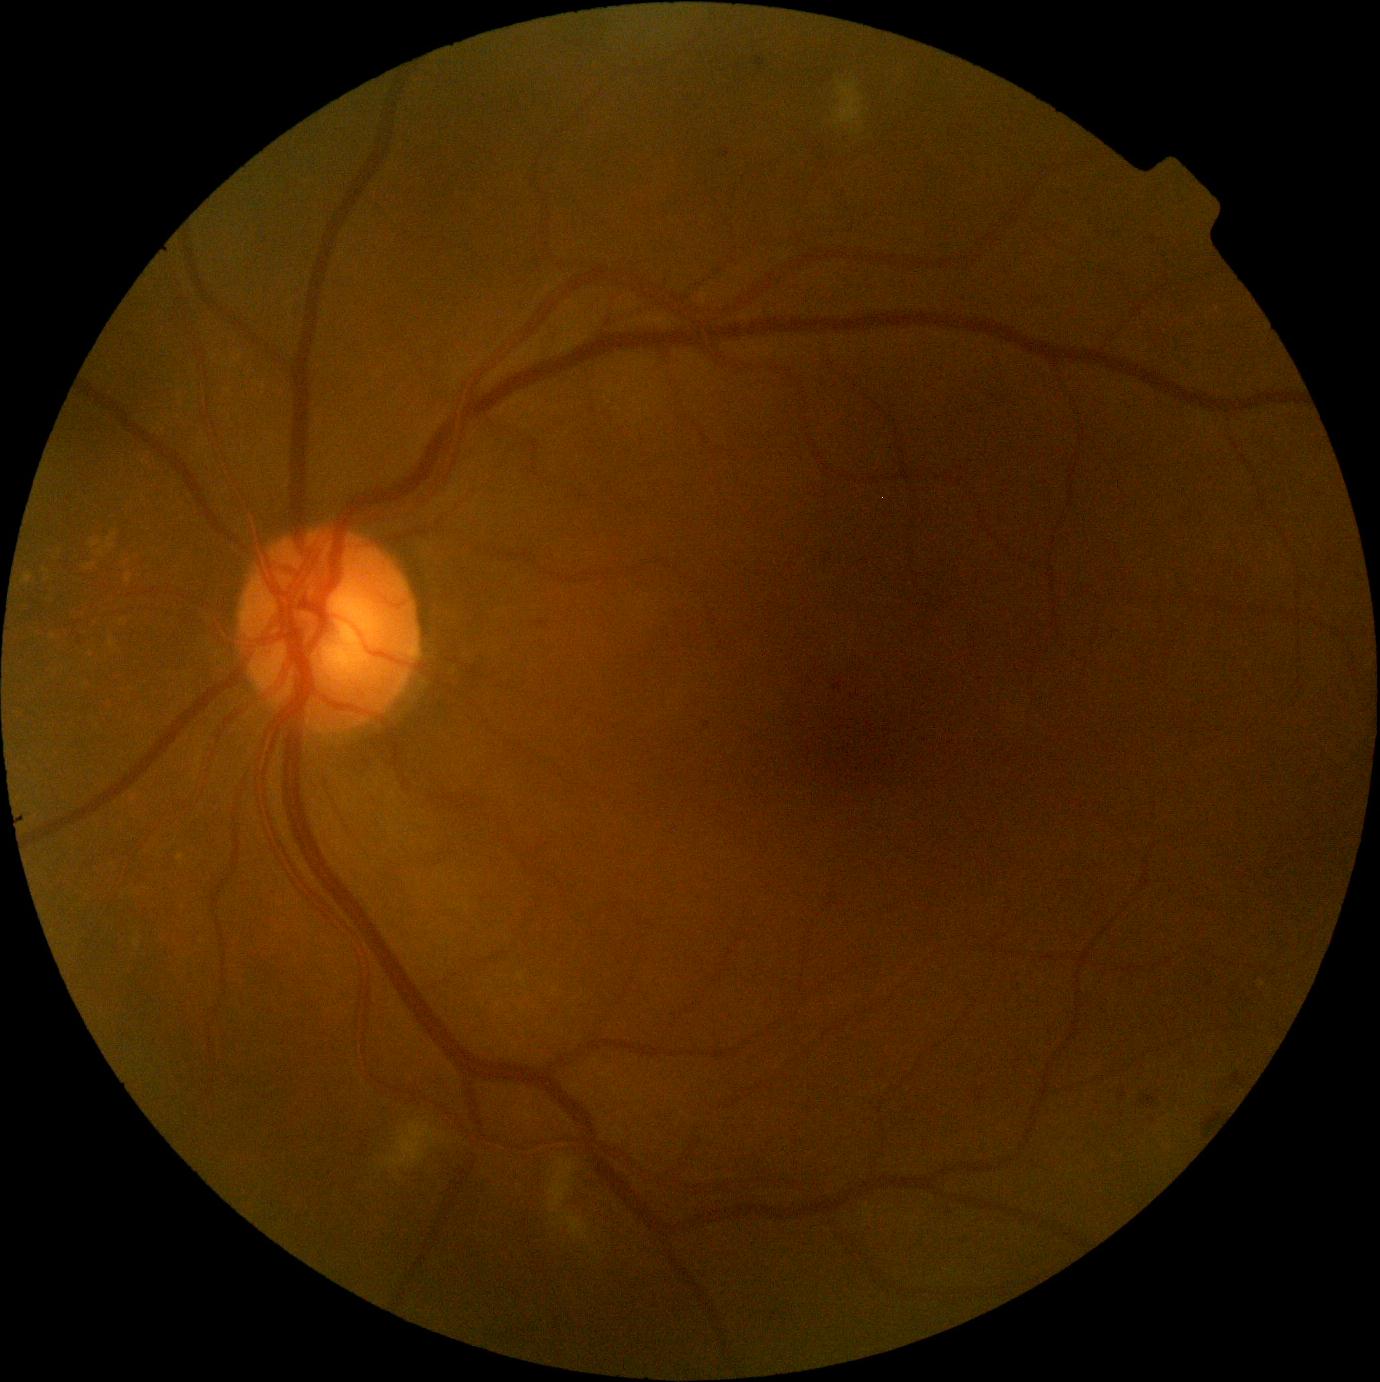

Diabetic retinopathy (DR) is moderate NPDR (grade 2) — more than just microaneurysms but less than severe NPDR.